412x310px; retinal fundus photograph.
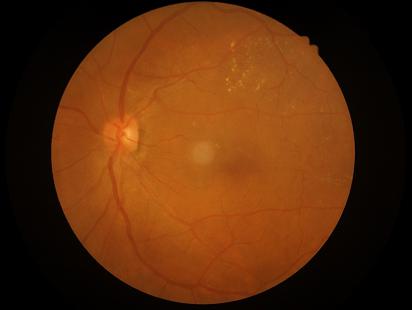
The image is clear. Adequate contrast for distinguishing structures. Overall image quality is good. Illumination and color balance are good.